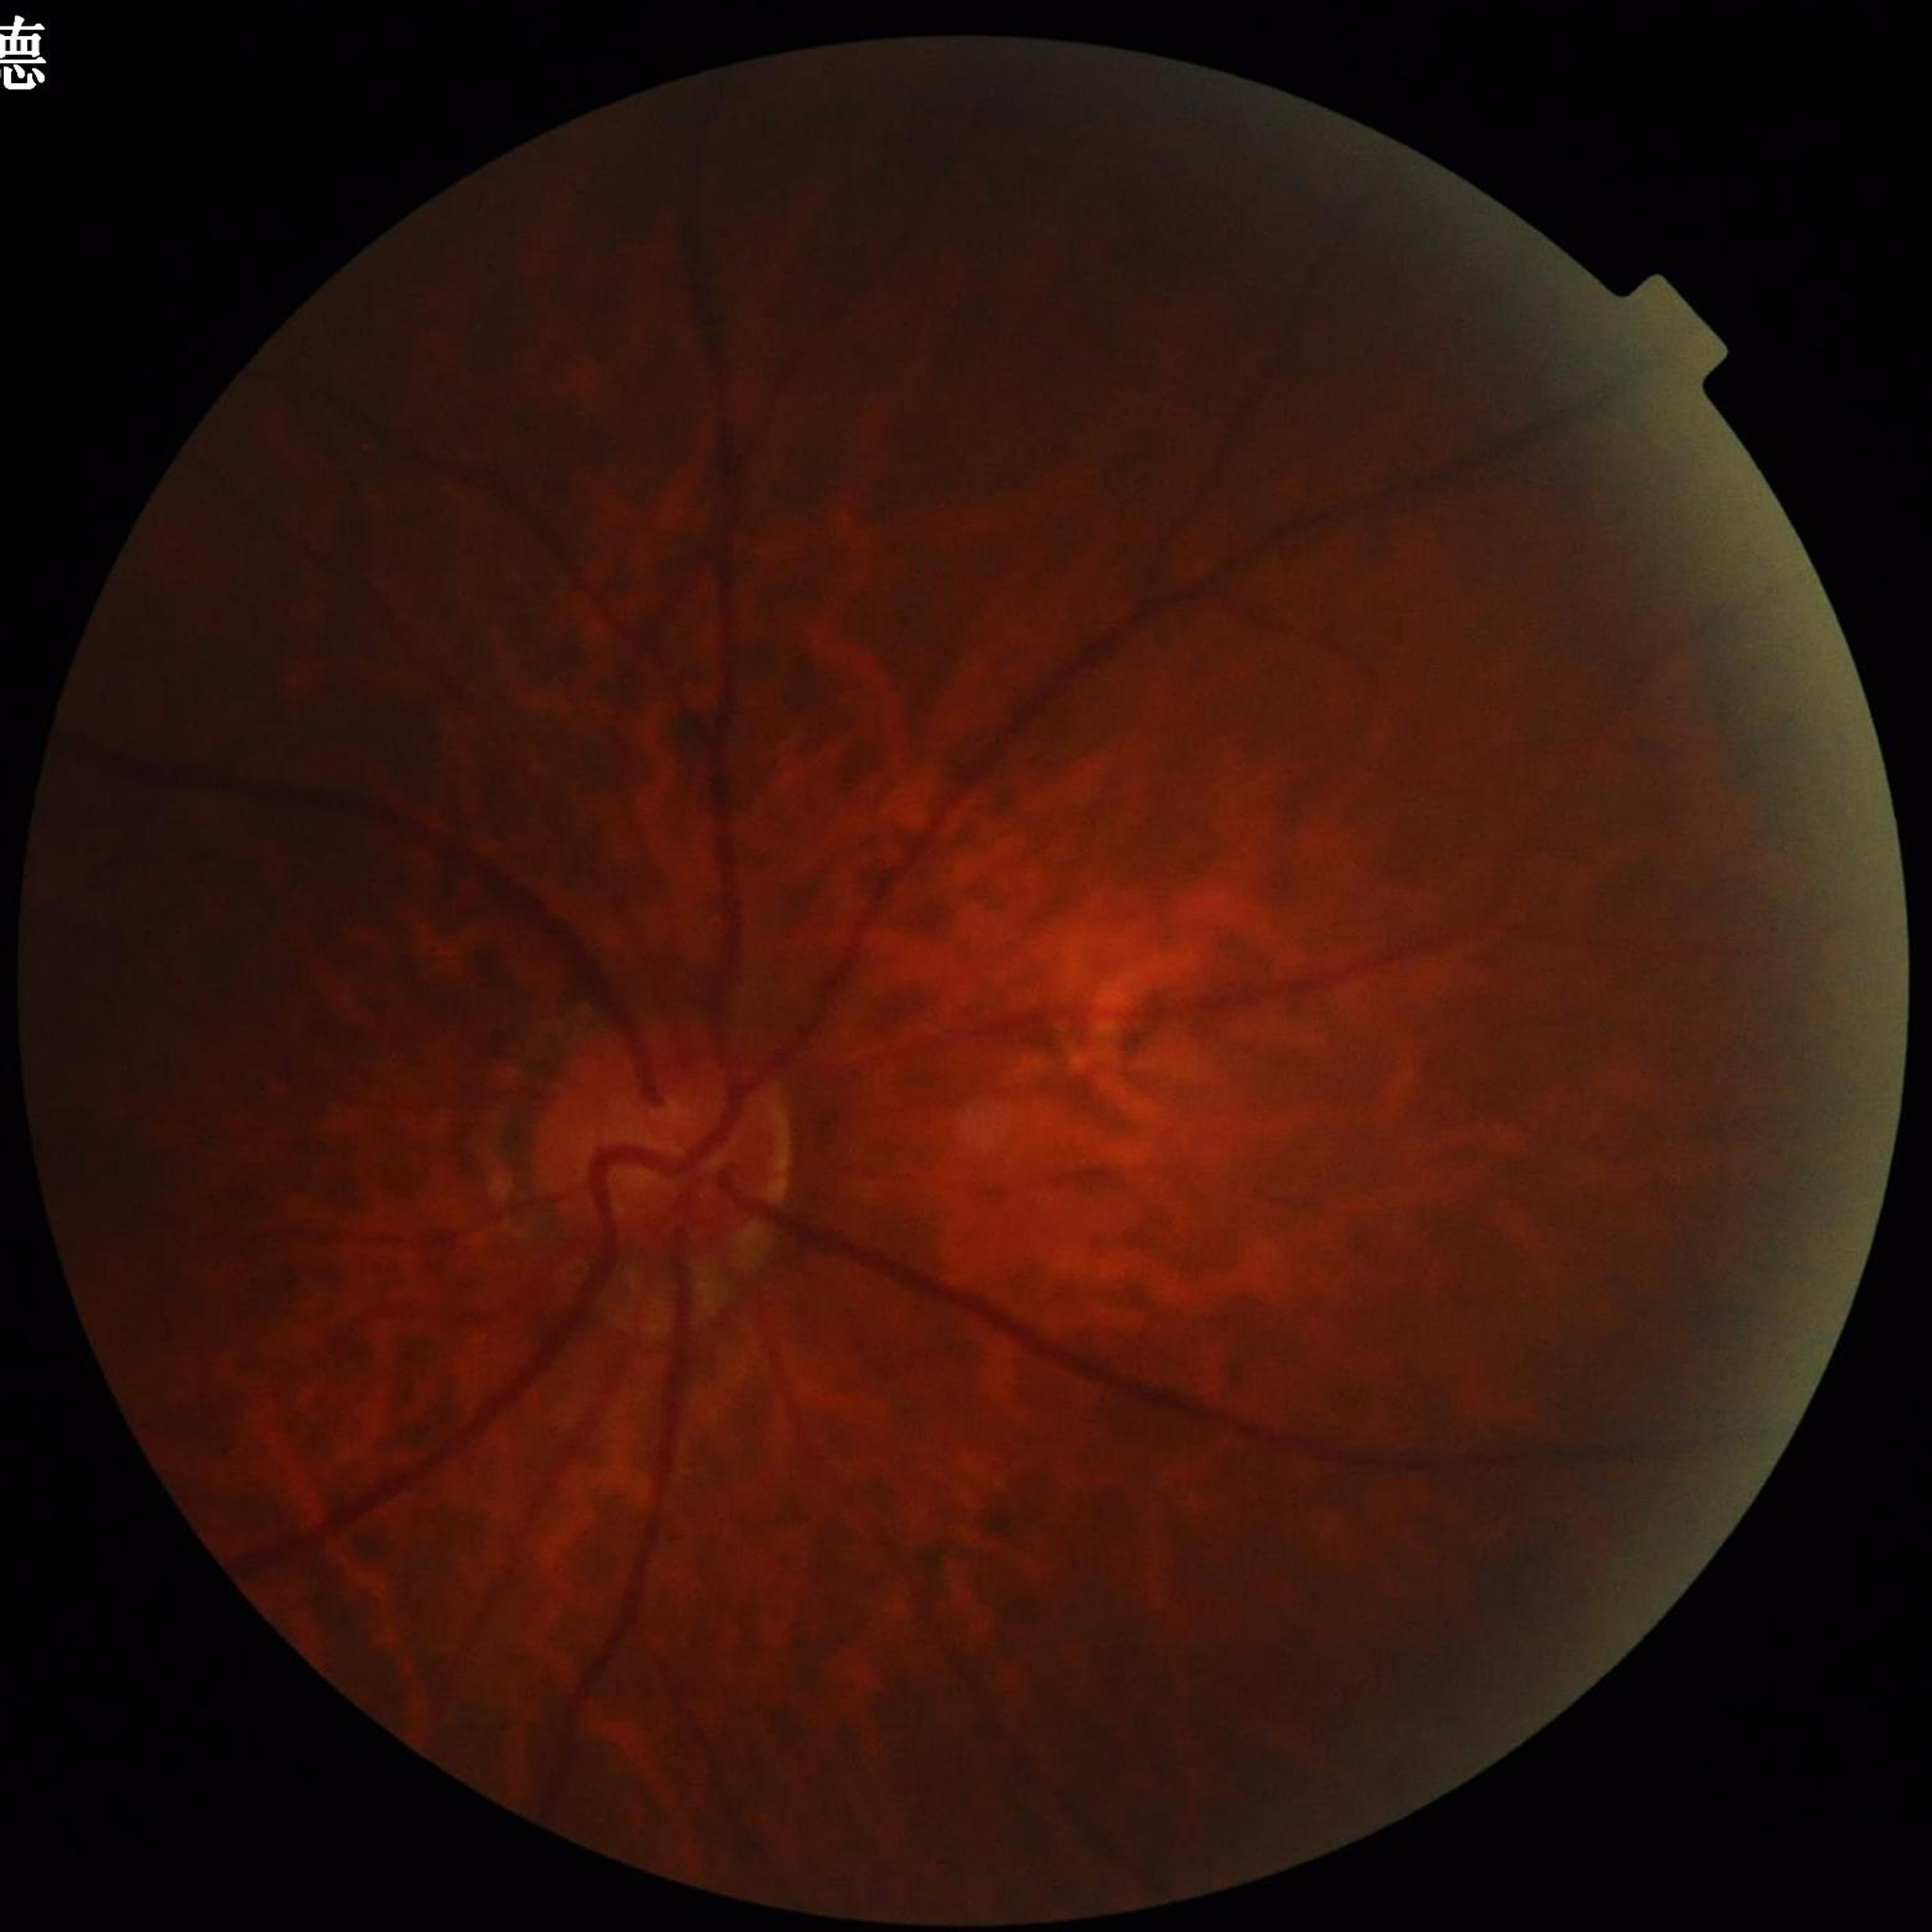 Clinical diagnosis: glaucoma
Automated quality assessment: issues noted — blur, illumination/color distortion